Fundus photo:
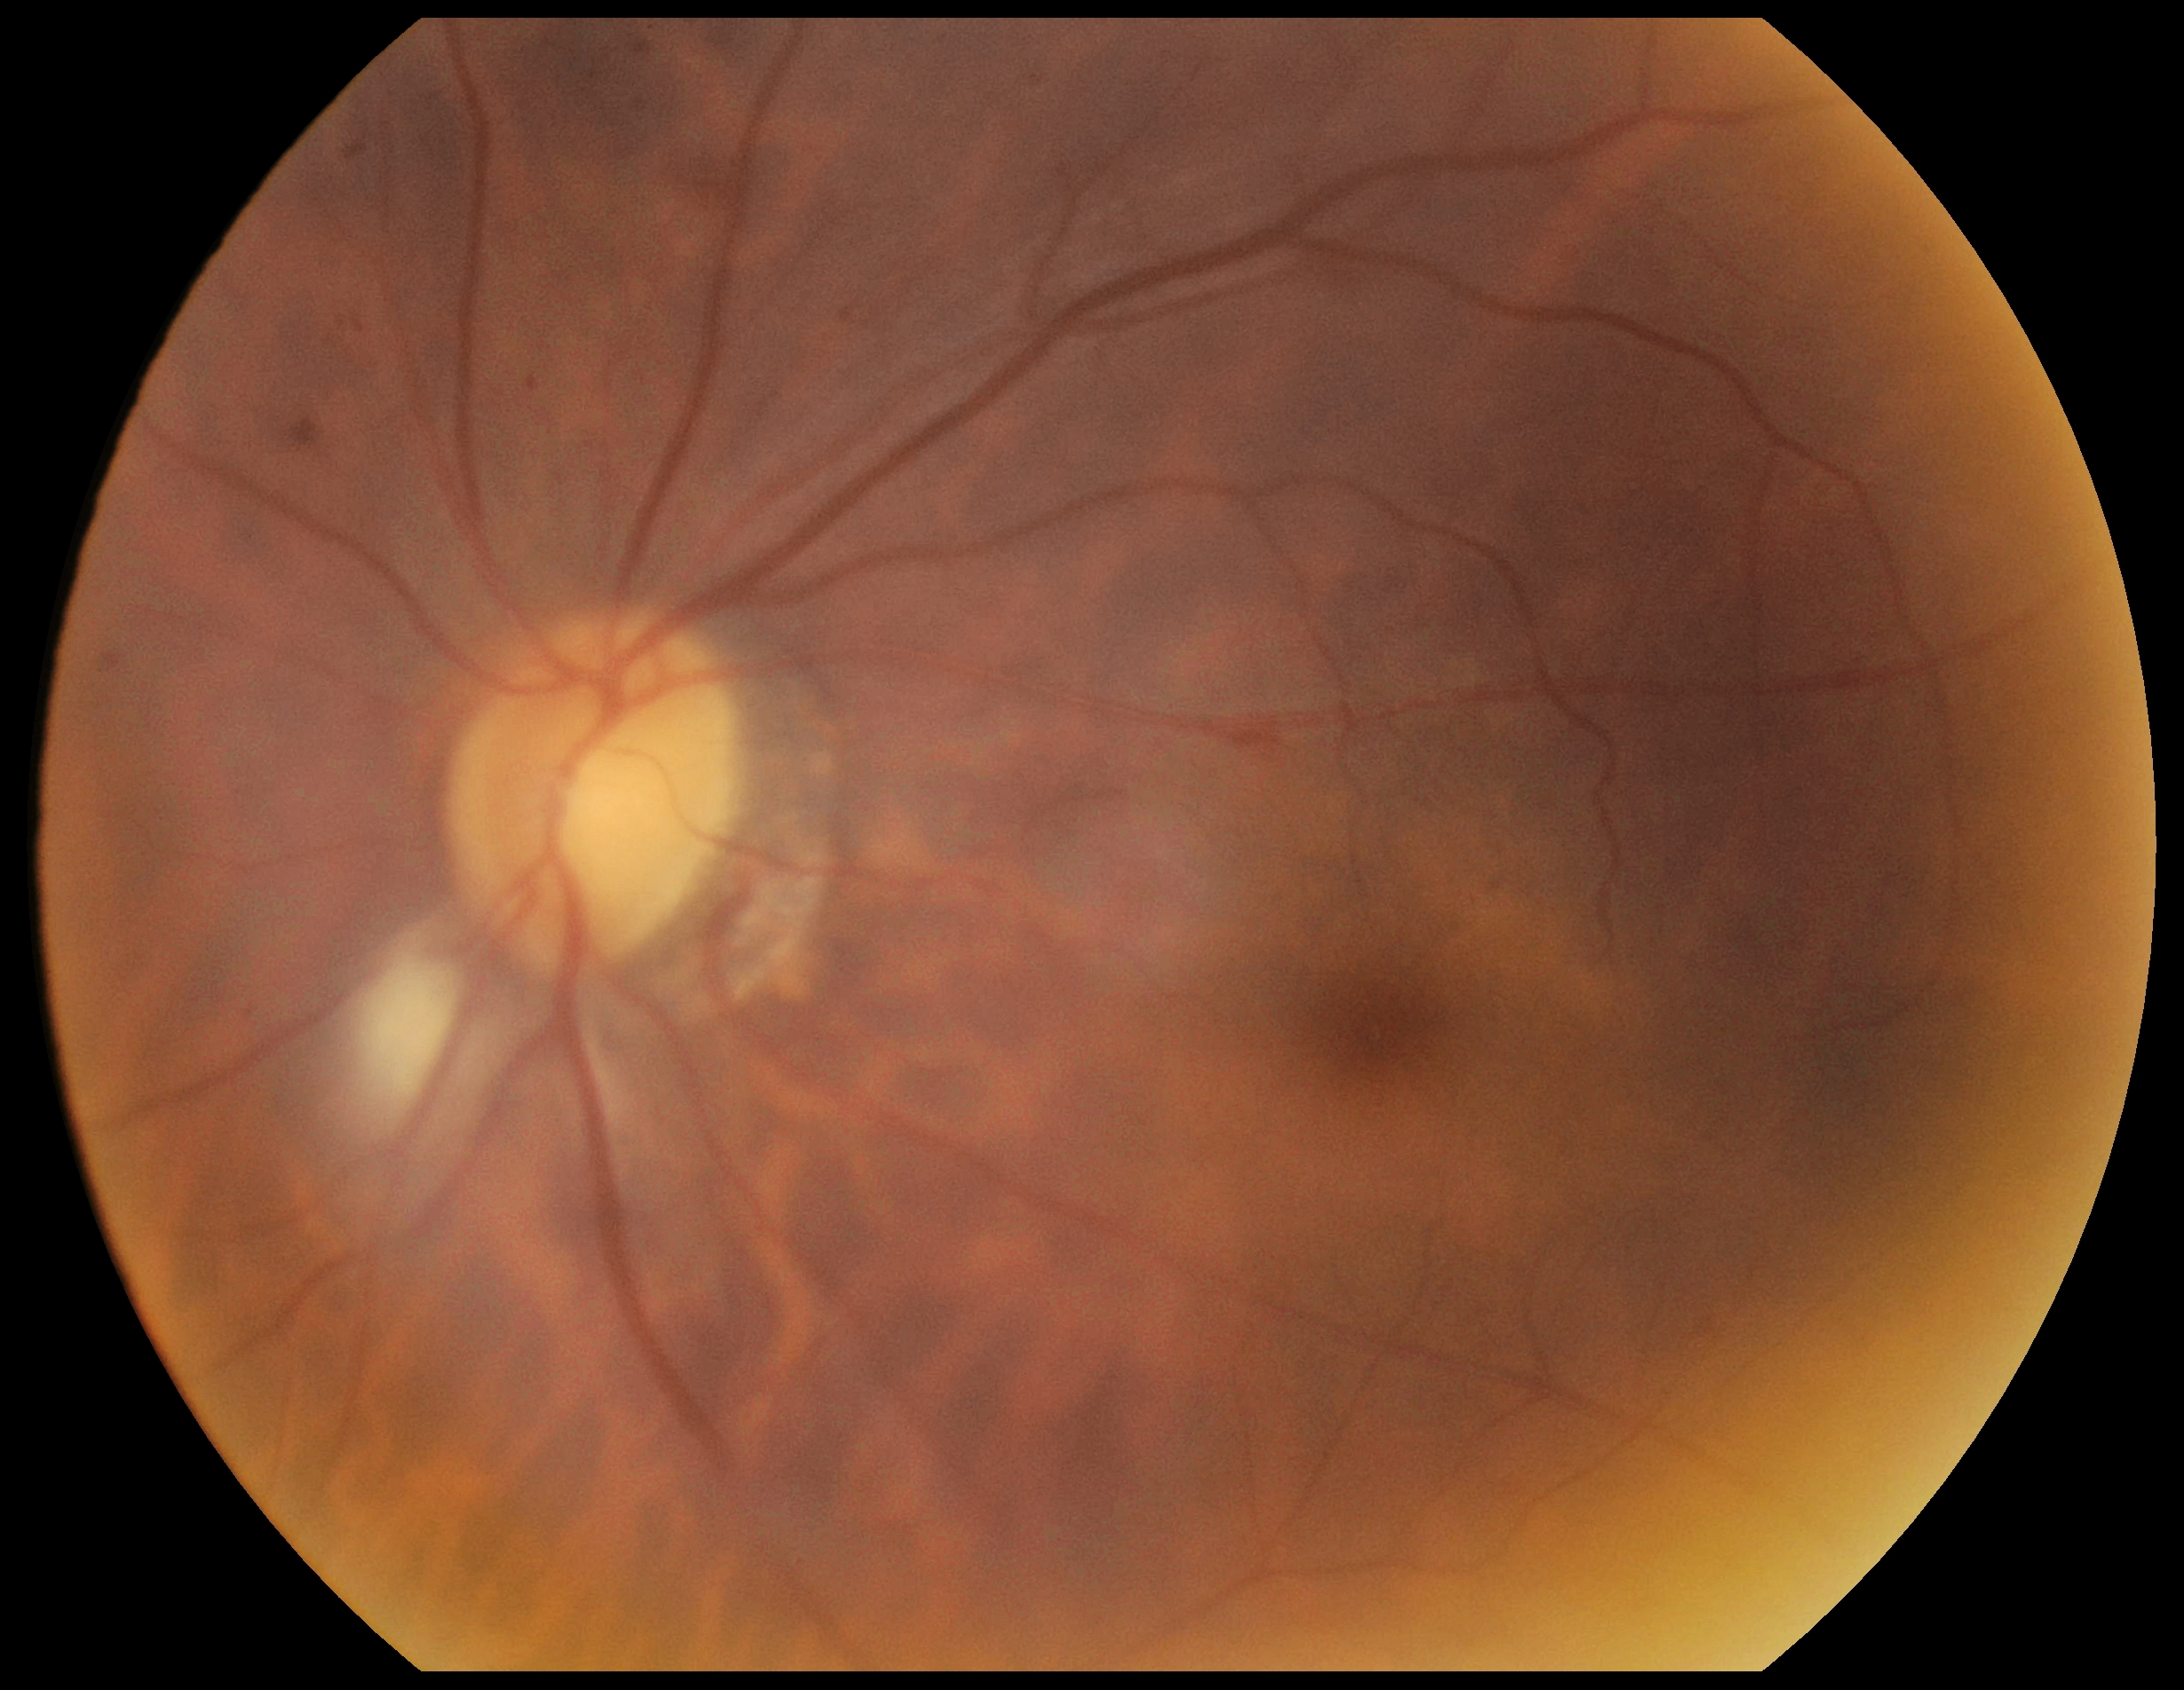
{
  "dr_category": "non-proliferative diabetic retinopathy",
  "dr_grade": "2/4 — more than just microaneurysms but less than severe NPDR"
}